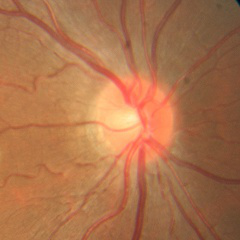
Demonstrates no glaucomatous changes.